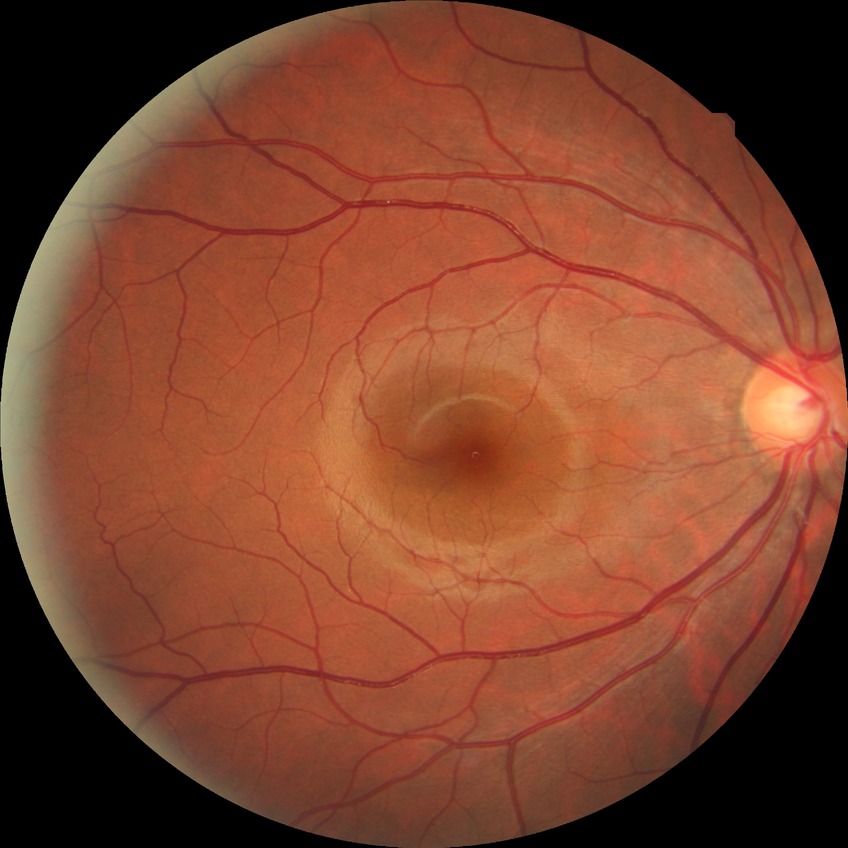

Diabetic retinopathy (DR) is NDR (no diabetic retinopathy).